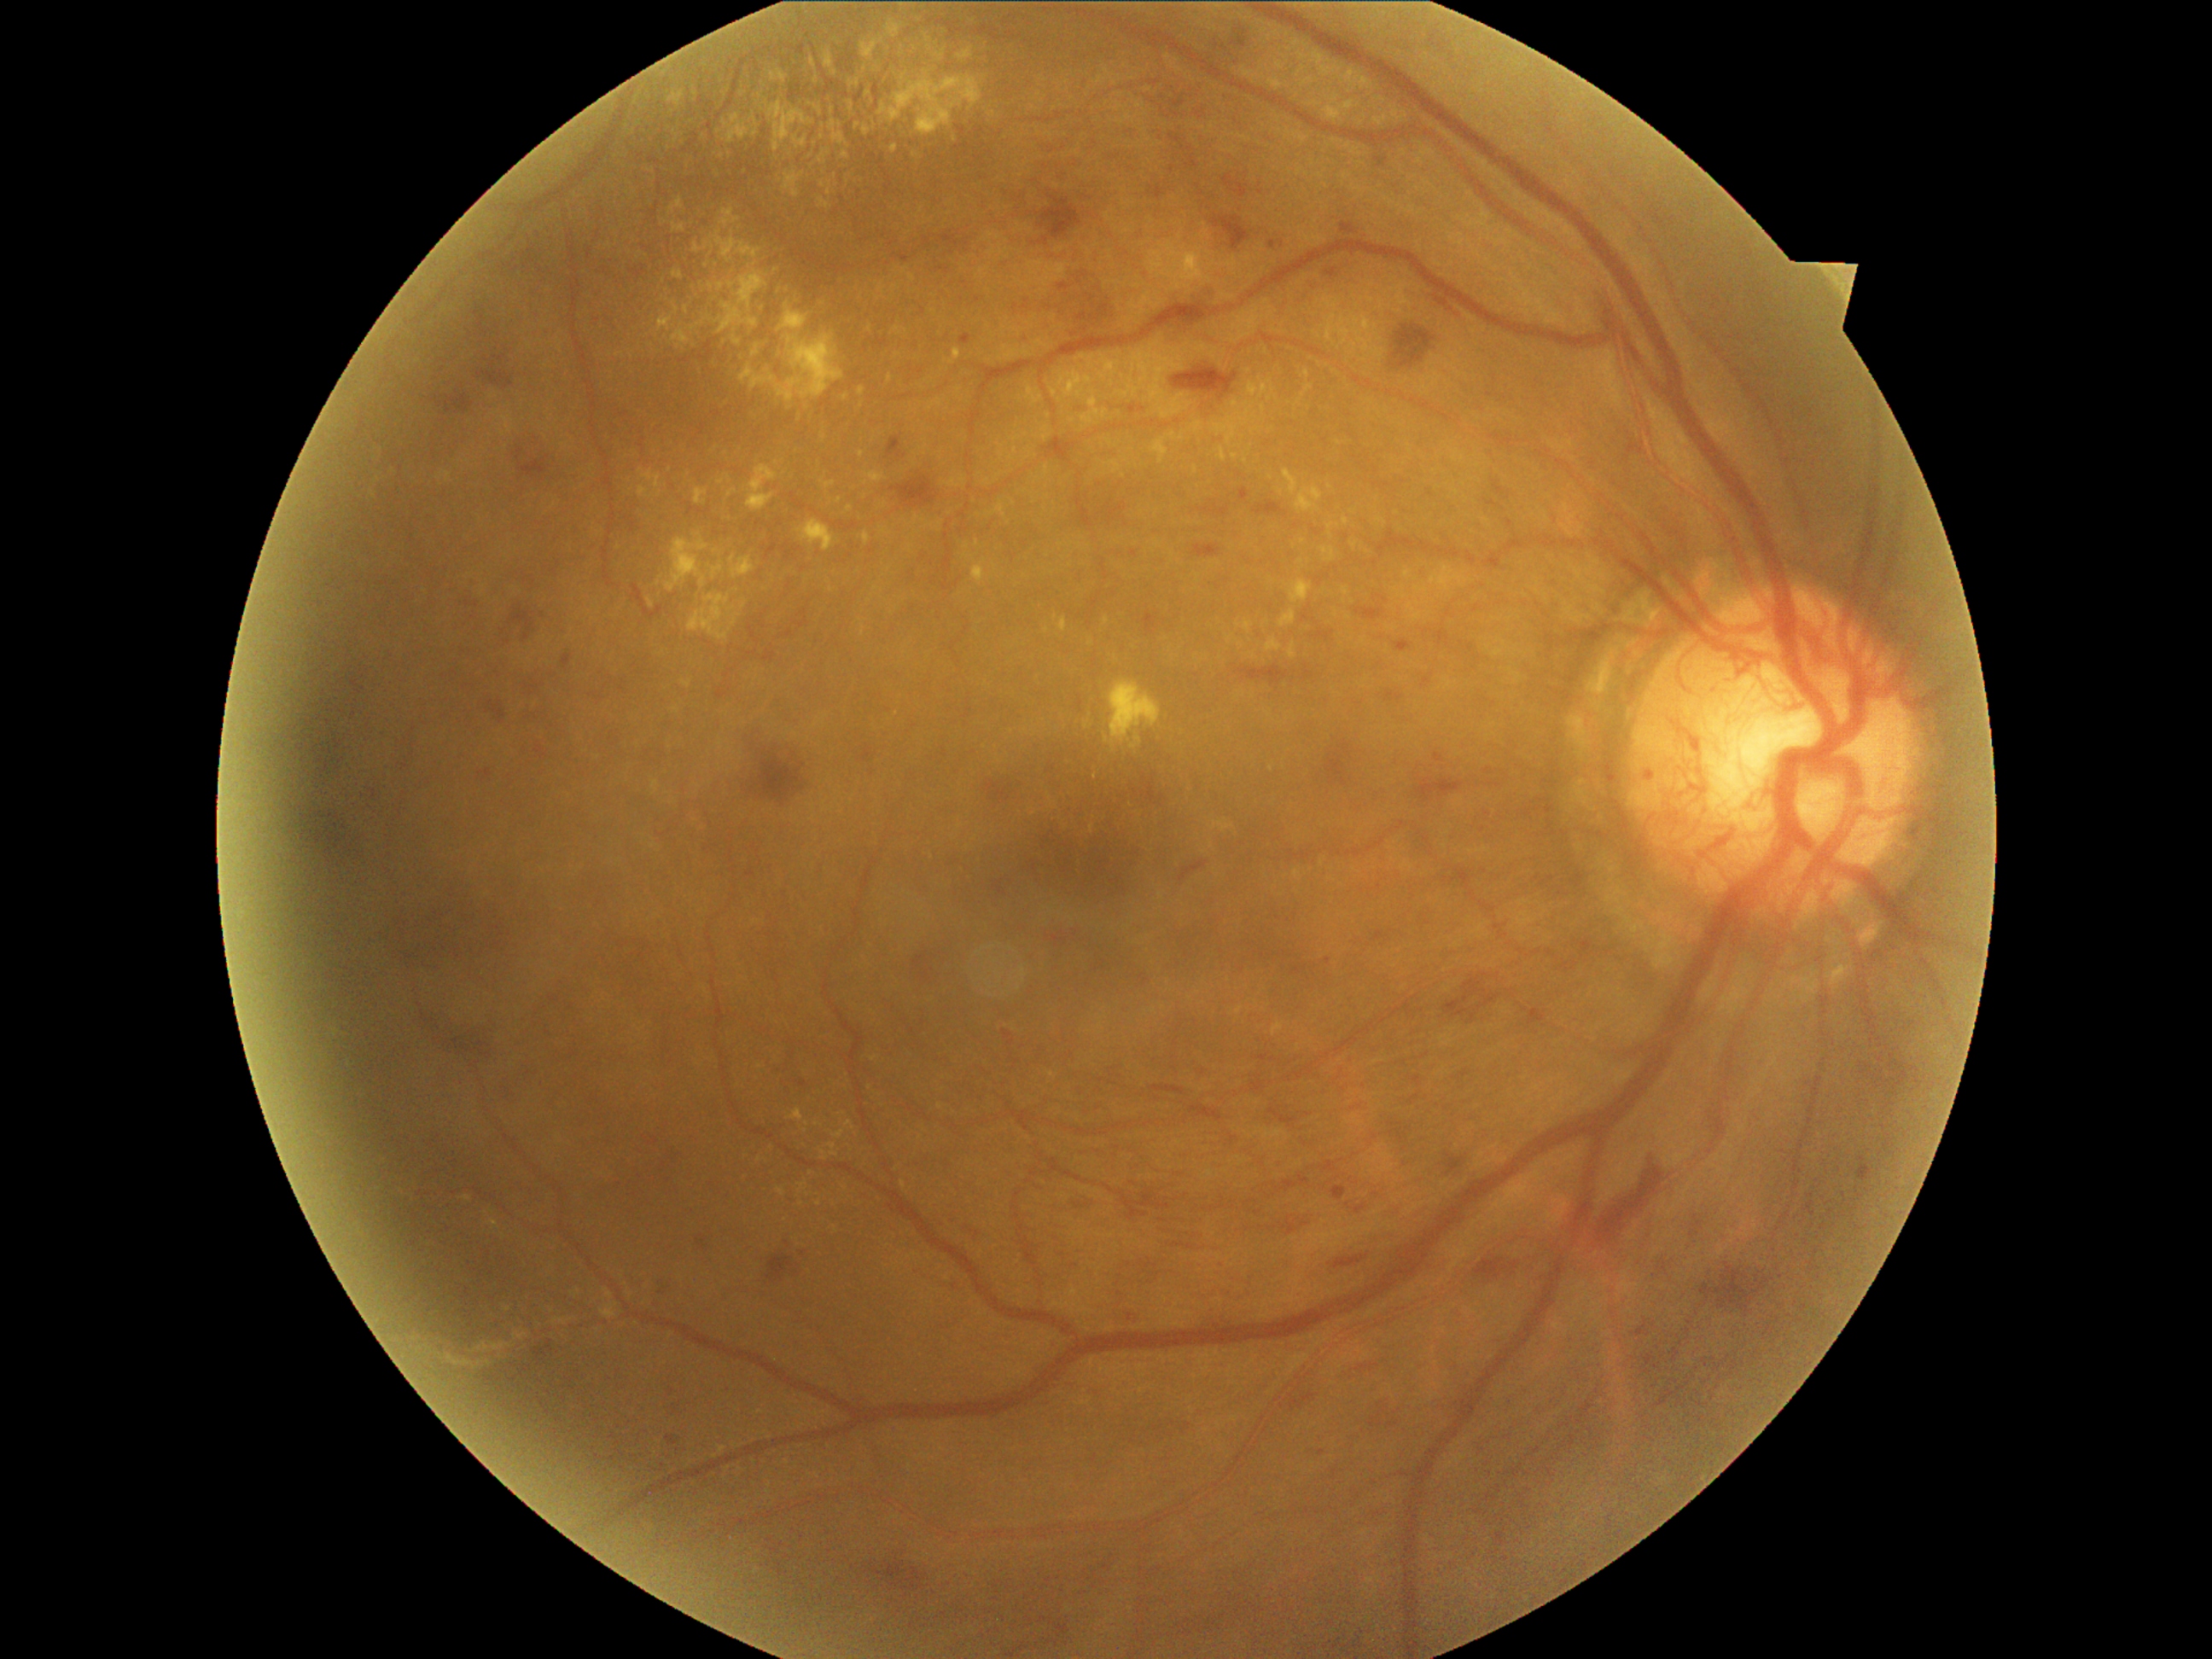

DR severity is grade 4 (PDR)
A subset of detected lesions:
EXs (partial): box(1289, 581, 1313, 605), box(882, 528, 890, 533), box(1027, 387, 1044, 407), box(868, 472, 887, 484), box(1105, 462, 1122, 474), box(1358, 78, 1373, 88), box(800, 520, 835, 550), box(822, 480, 835, 489), box(728, 491, 736, 498), box(936, 52, 946, 61), box(878, 67, 982, 137), box(863, 532, 871, 544), box(847, 102, 854, 112), box(1281, 610, 1296, 627)
Additional small EXs near [719, 131], [897, 331], [631, 1295], [676, 710], [871, 329], [803, 1204]
HEs (partial): box(1445, 972, 1505, 1025), box(1858, 1156, 1873, 1182), box(1201, 501, 1230, 518), box(986, 781, 1013, 803), box(1250, 1208, 1327, 1237), box(463, 595, 484, 612), box(1595, 1156, 1665, 1243), box(890, 472, 940, 509), box(1322, 1161, 1337, 1172), box(1370, 1414, 1383, 1426), box(1325, 742, 1349, 788), box(1423, 779, 1469, 800), box(352, 711, 358, 719), box(487, 701, 506, 723), box(325, 702, 346, 714), box(923, 238, 931, 247)
Additional small HEs near [324, 694]